Posterior pole color fundus photograph, Davis DR grading, NIDEK AFC-230 — 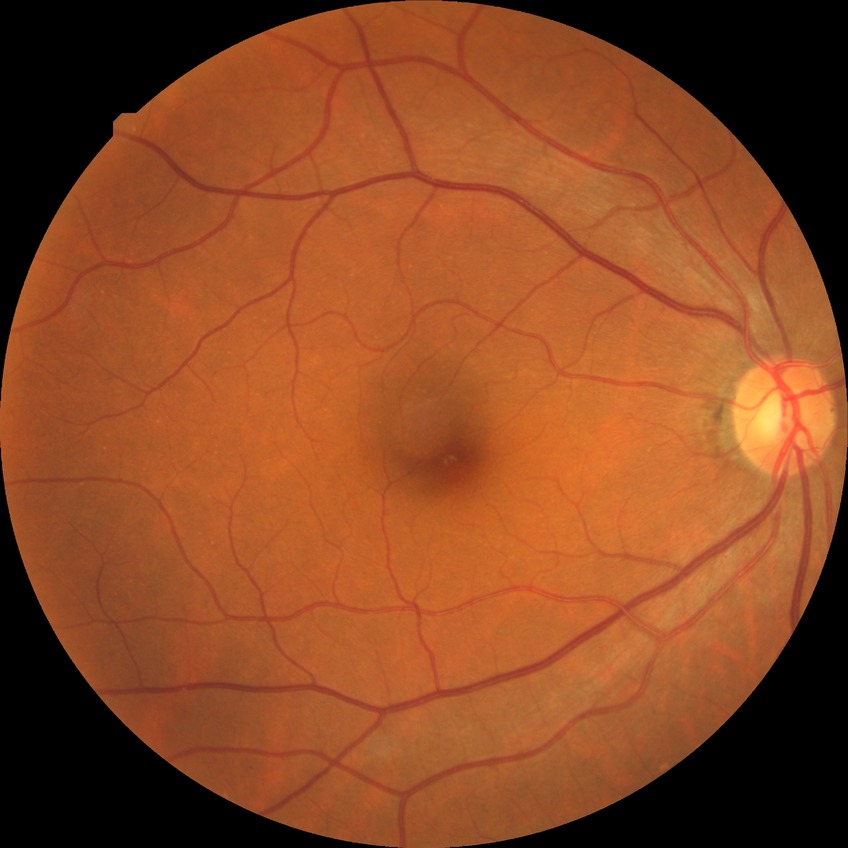
Diabetic retinopathy severity: no diabetic retinopathy.